Retinal fundus photograph:
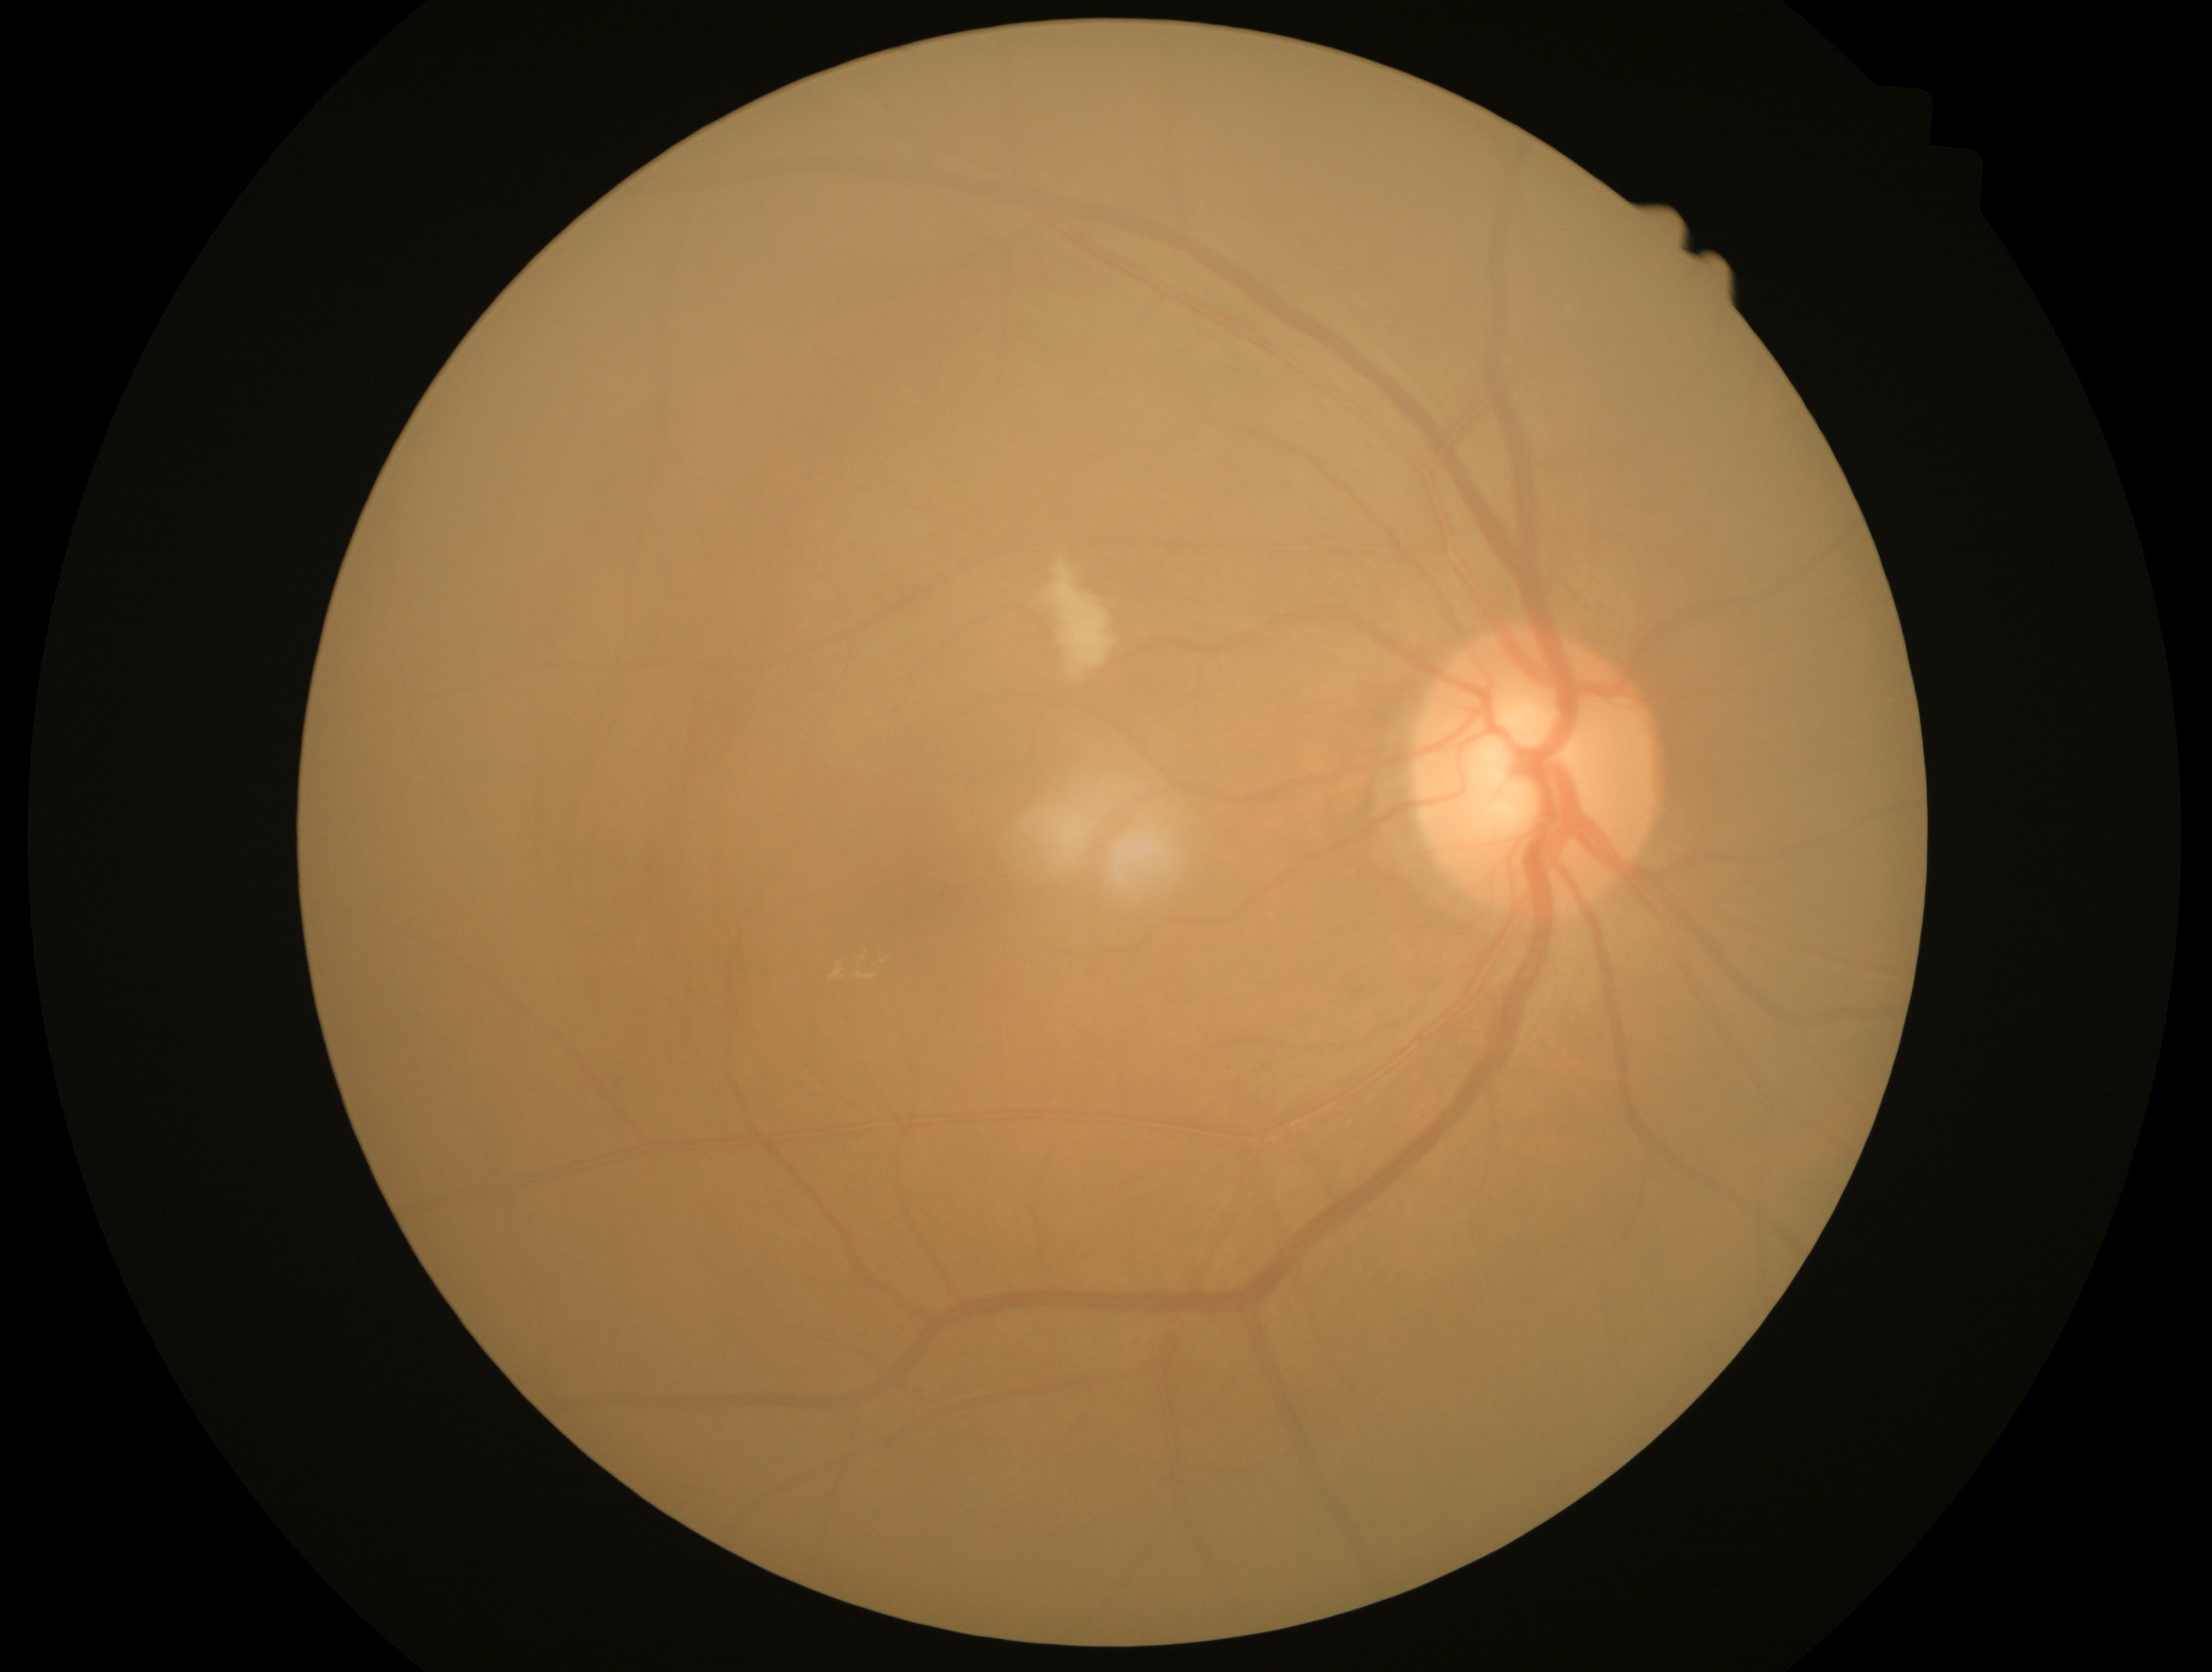

Annotations:
• DR class: non-proliferative diabetic retinopathy
• DR severity: grade 2 (moderate NPDR)